NIDEK AFC-230: 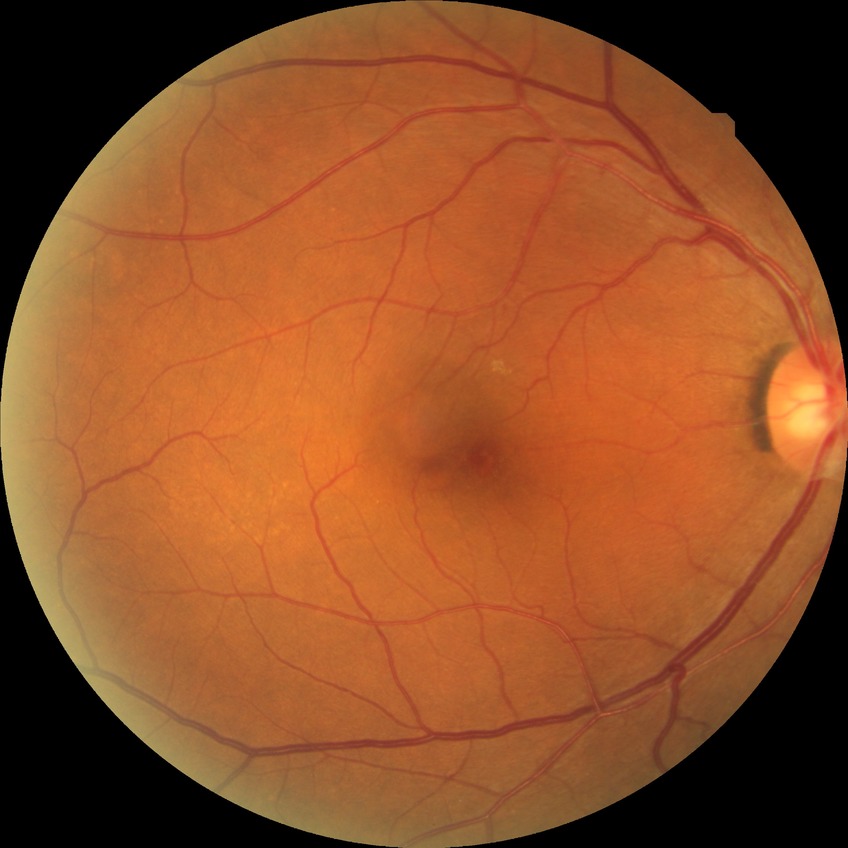
Diabetic retinopathy (DR): NDR (no diabetic retinopathy).